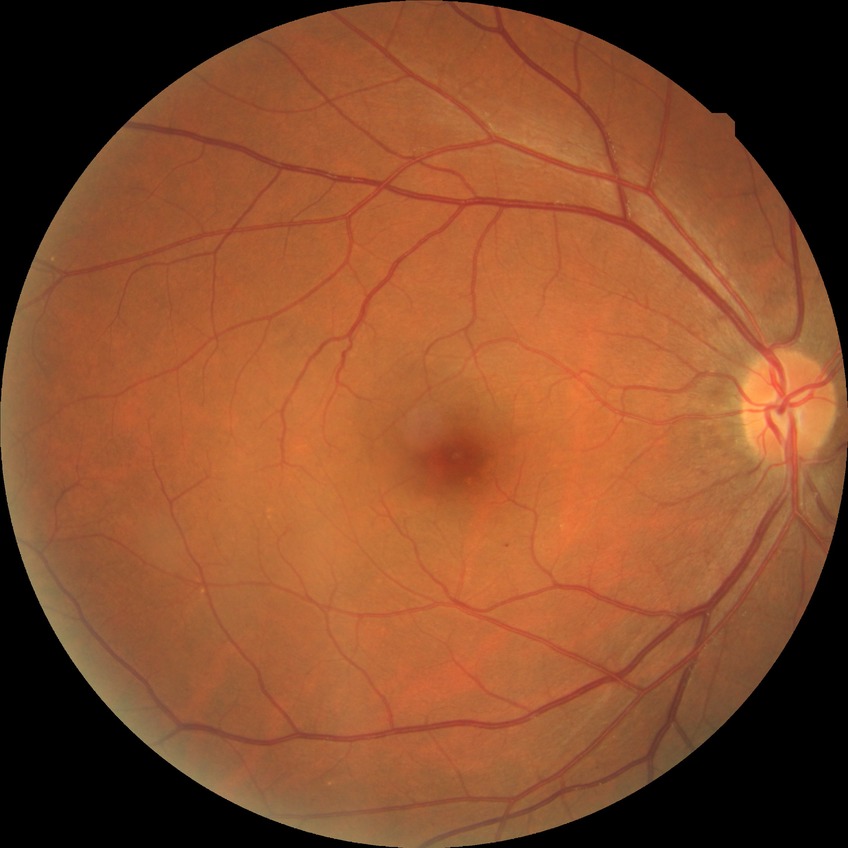

Davis stage: NDR.